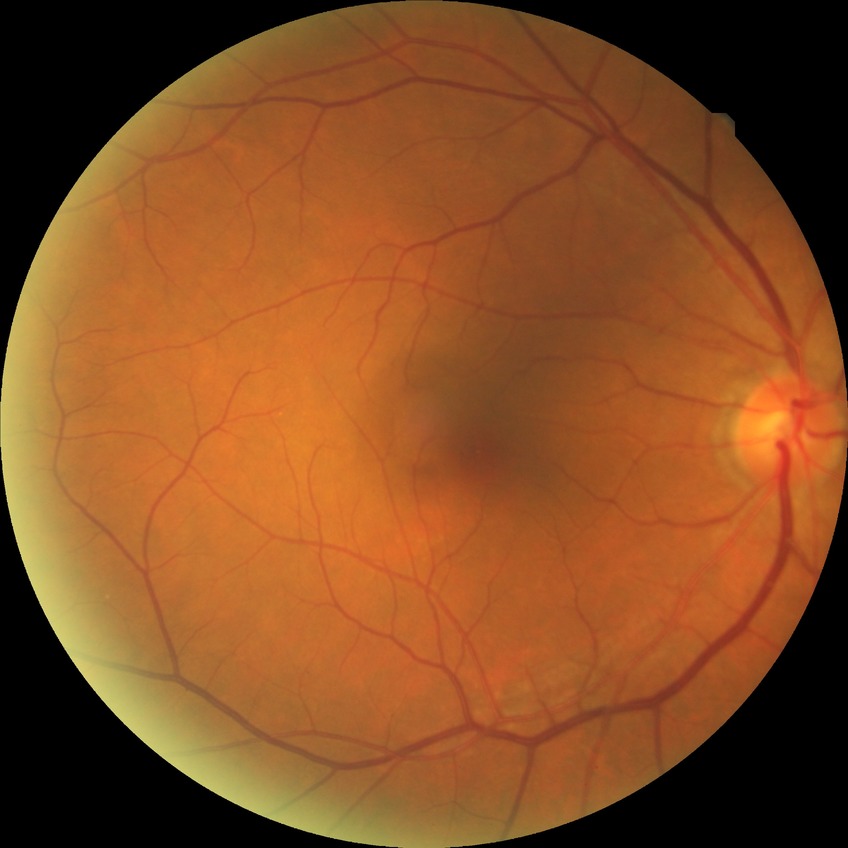
- DR grade — NDR